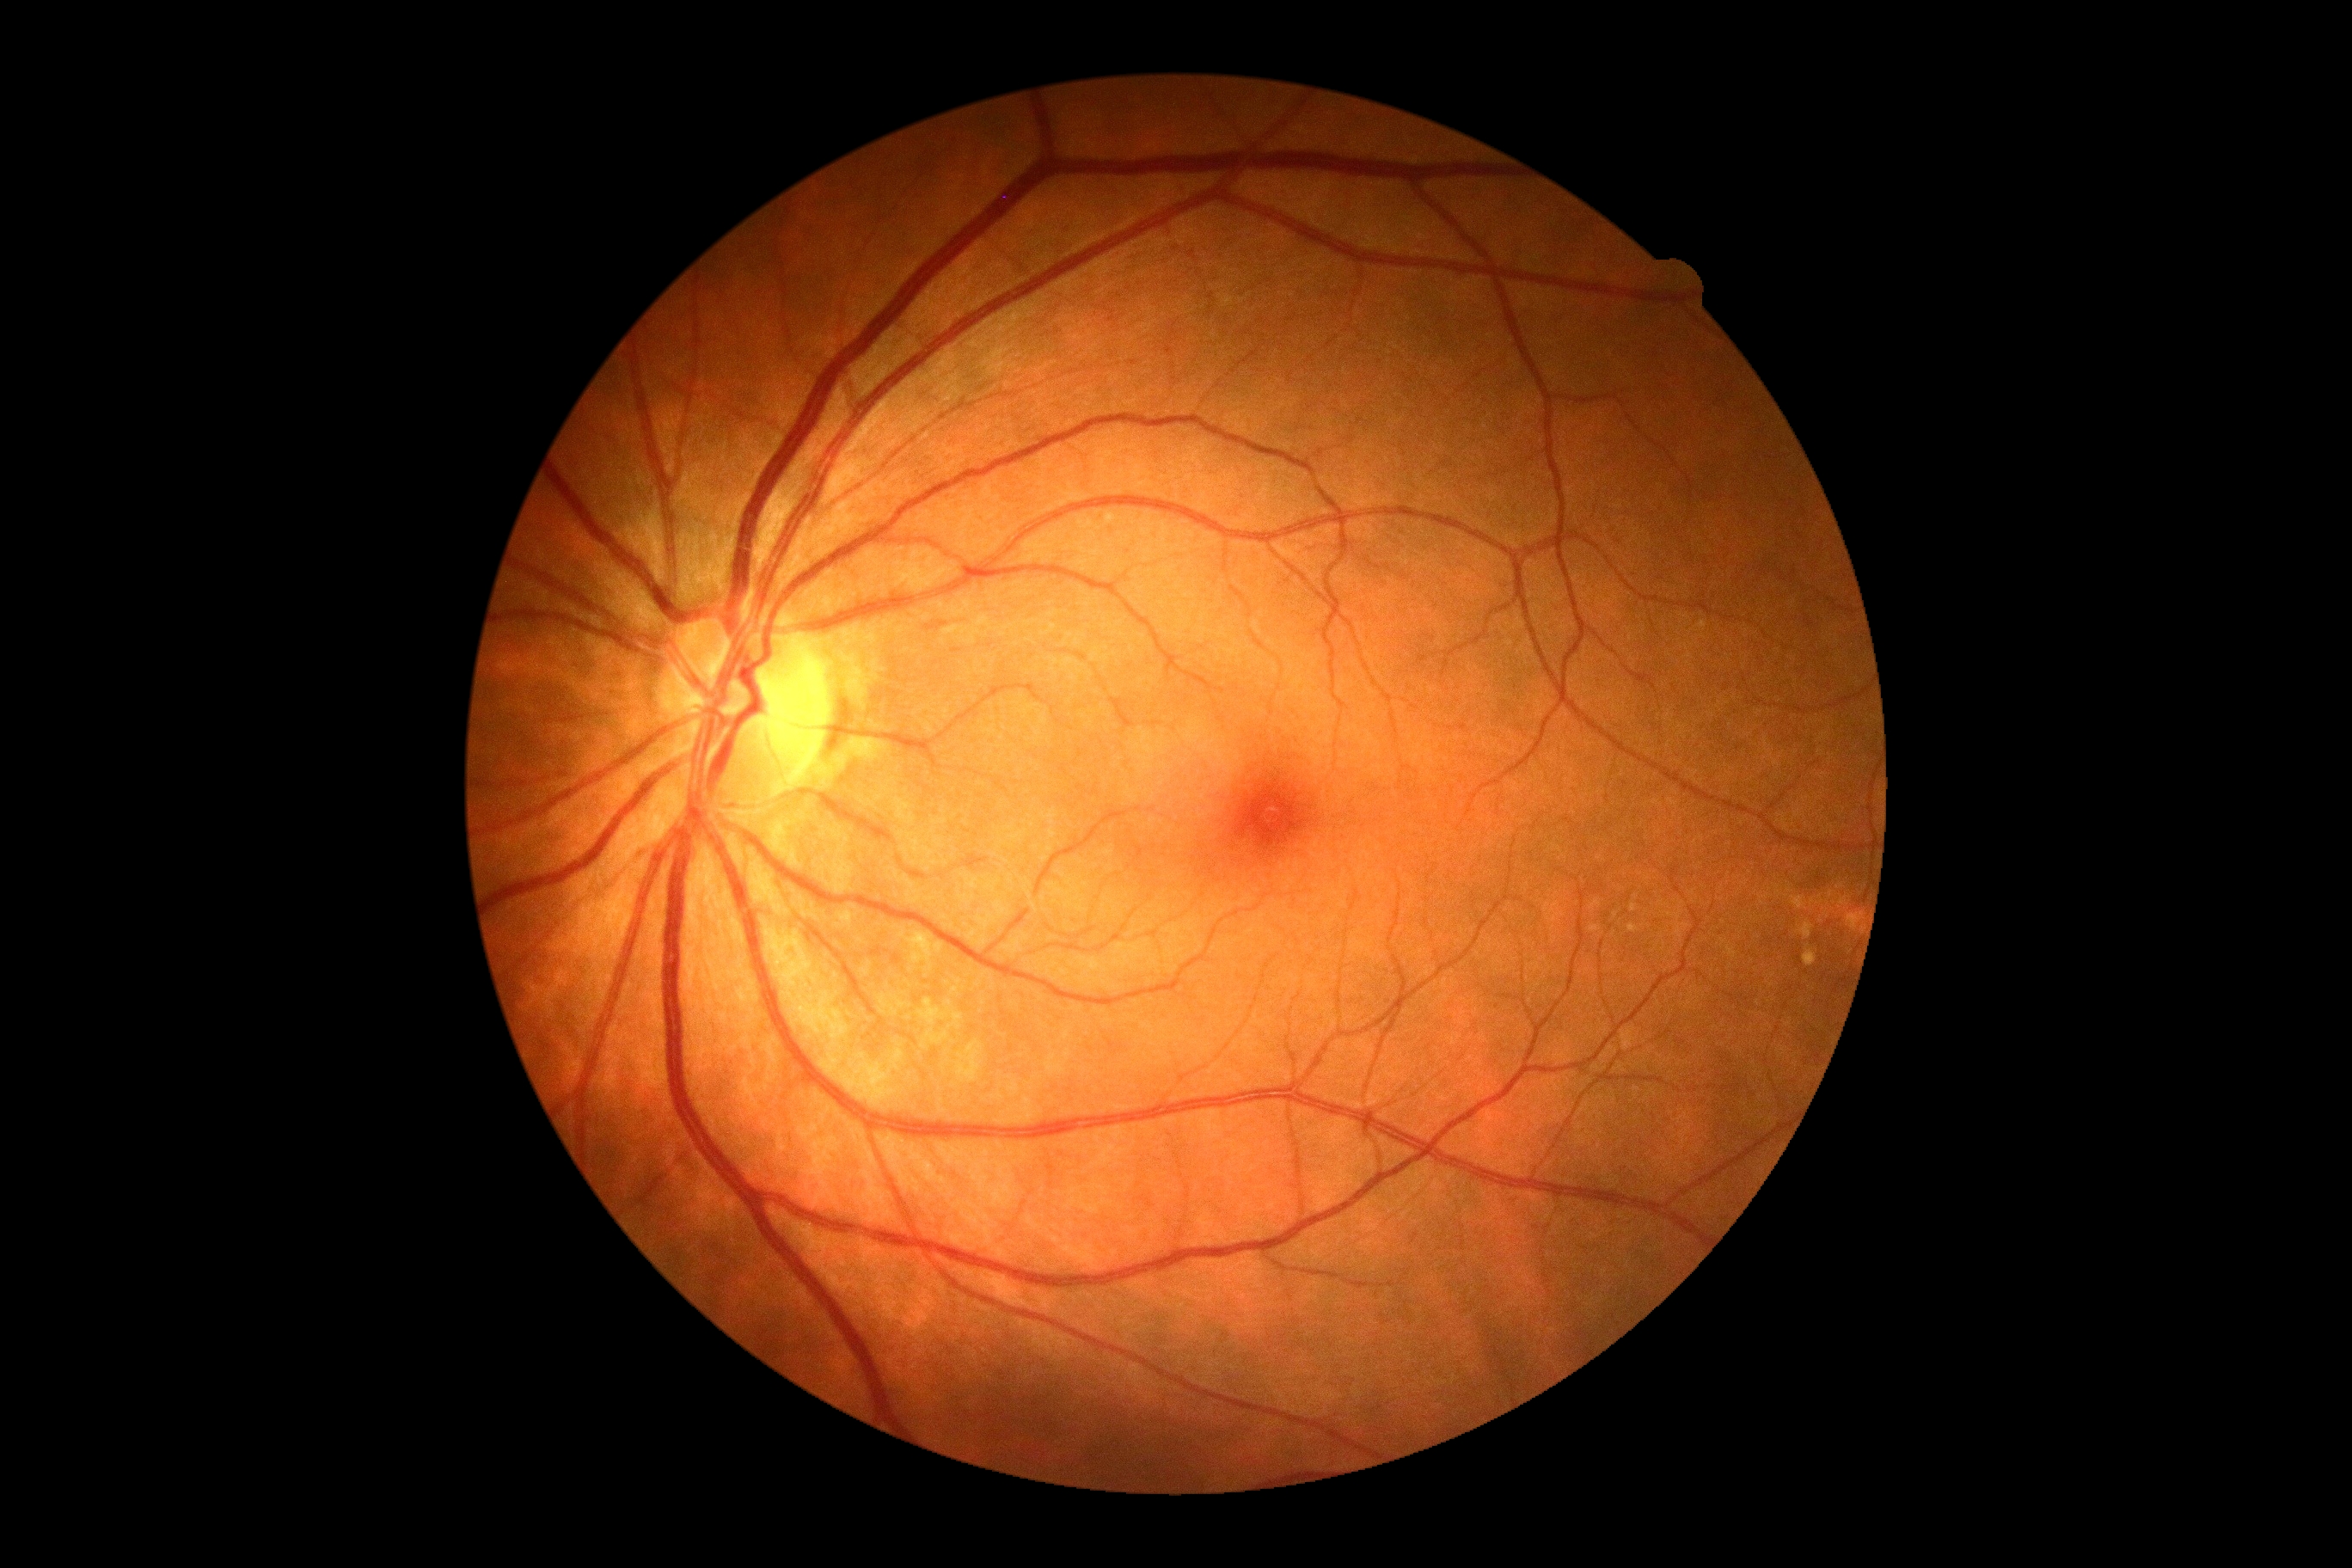
Diabetic retinopathy: grade 0.